Color fundus image · Davis DR grading · NIDEK AFC-230 fundus camera.
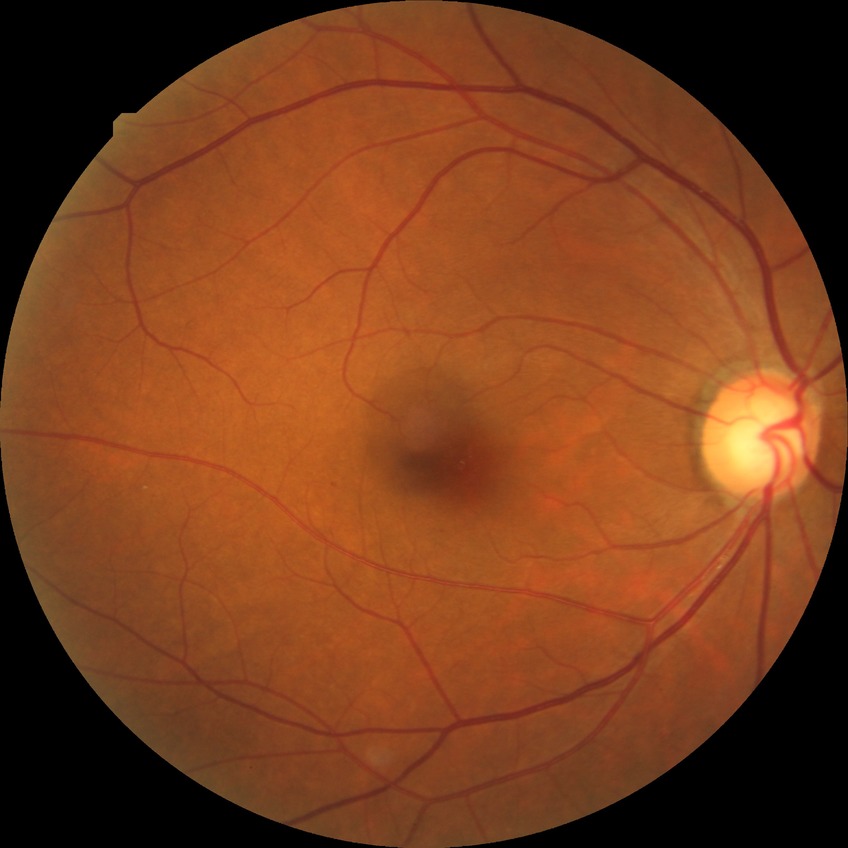

Assessment:
* diabetic retinopathy (DR) — simple diabetic retinopathy (SDR)